Infant wide-field fundus photograph · captured with the Phoenix ICON (100° field of view) — 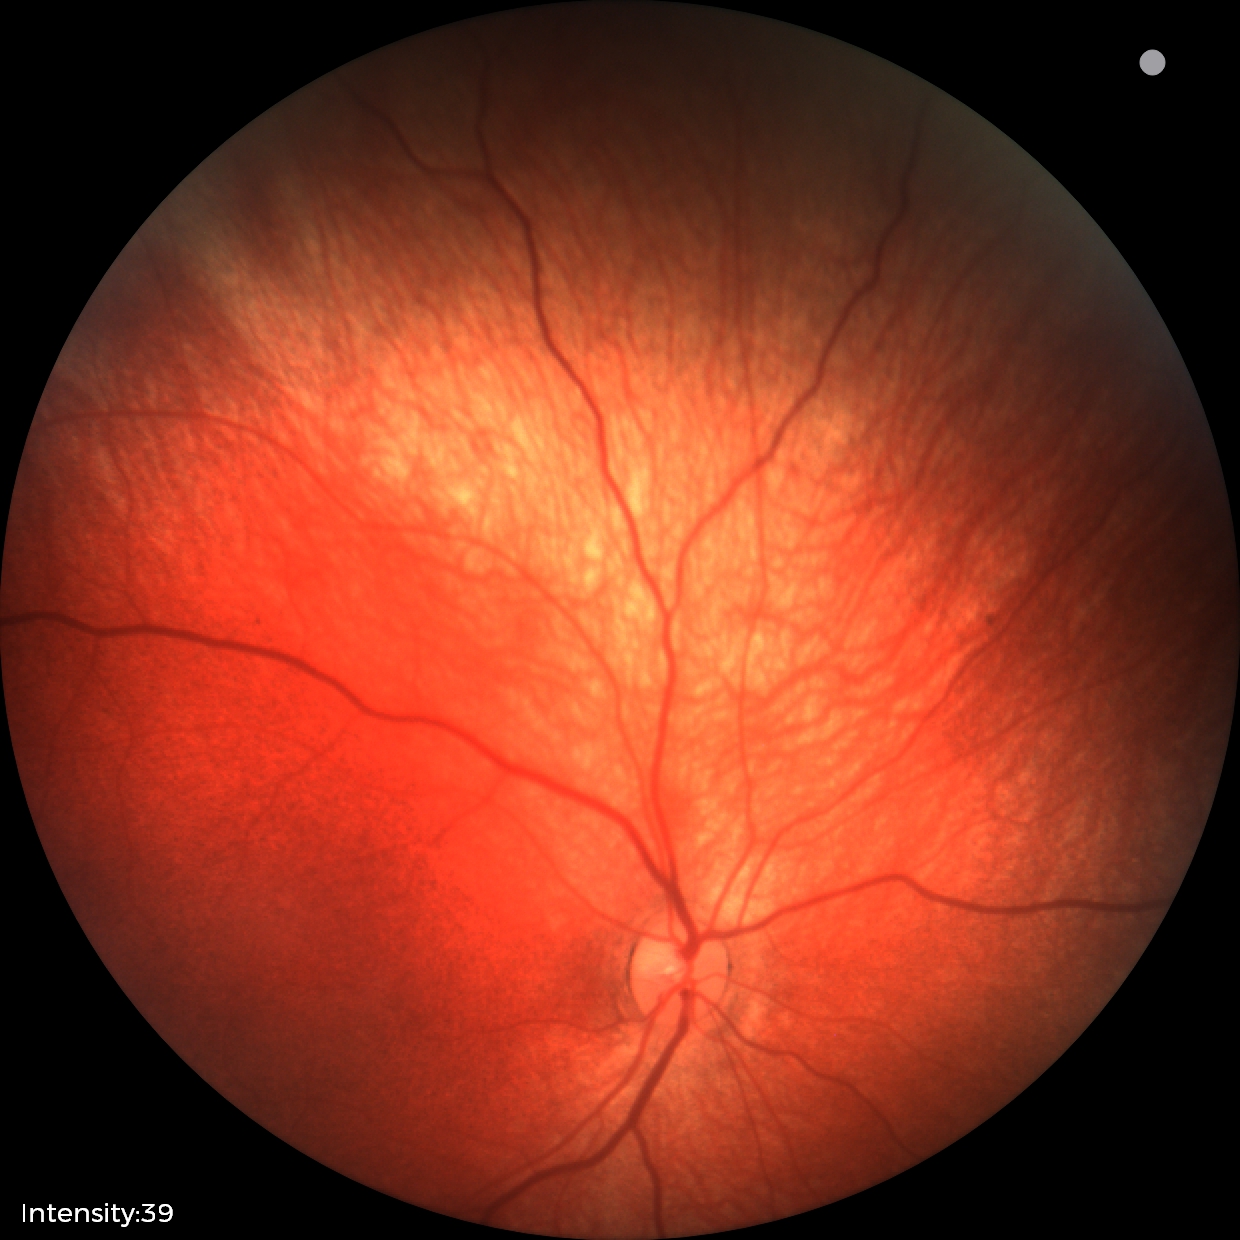
Series diagnosed as retinal hemorrhages.